Wide-field fundus photograph from neonatal ROP screening; captured with the Natus RetCam Envision (130° field of view); image size 1440x1080.
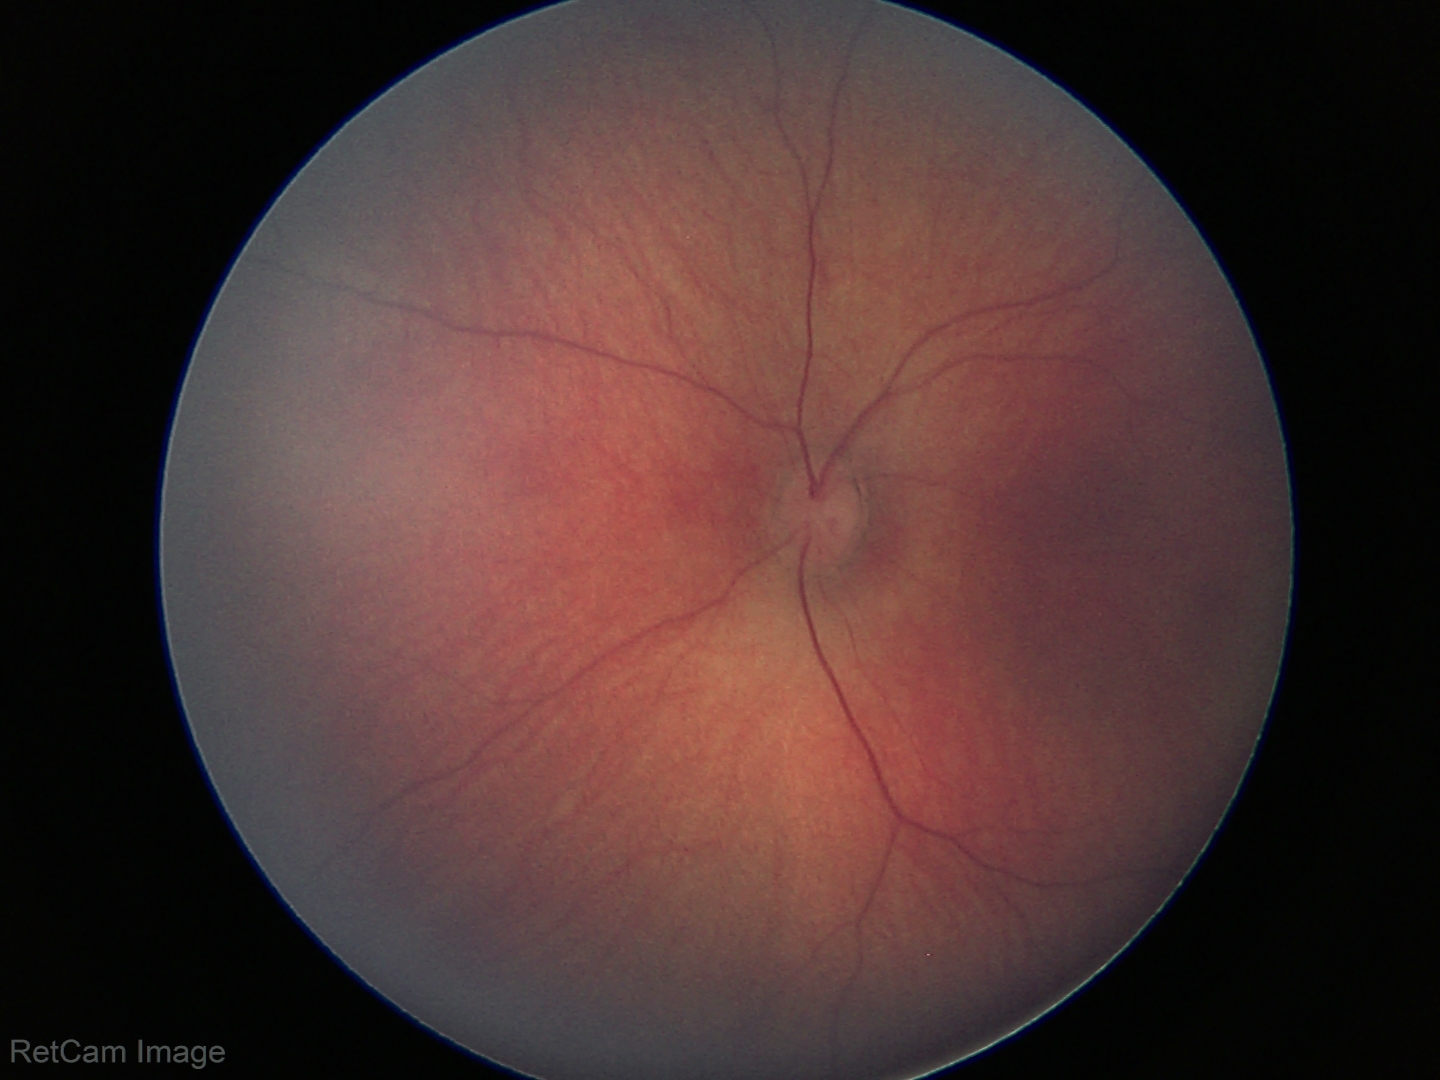

Finding = physiological.